Retinal fundus photograph — 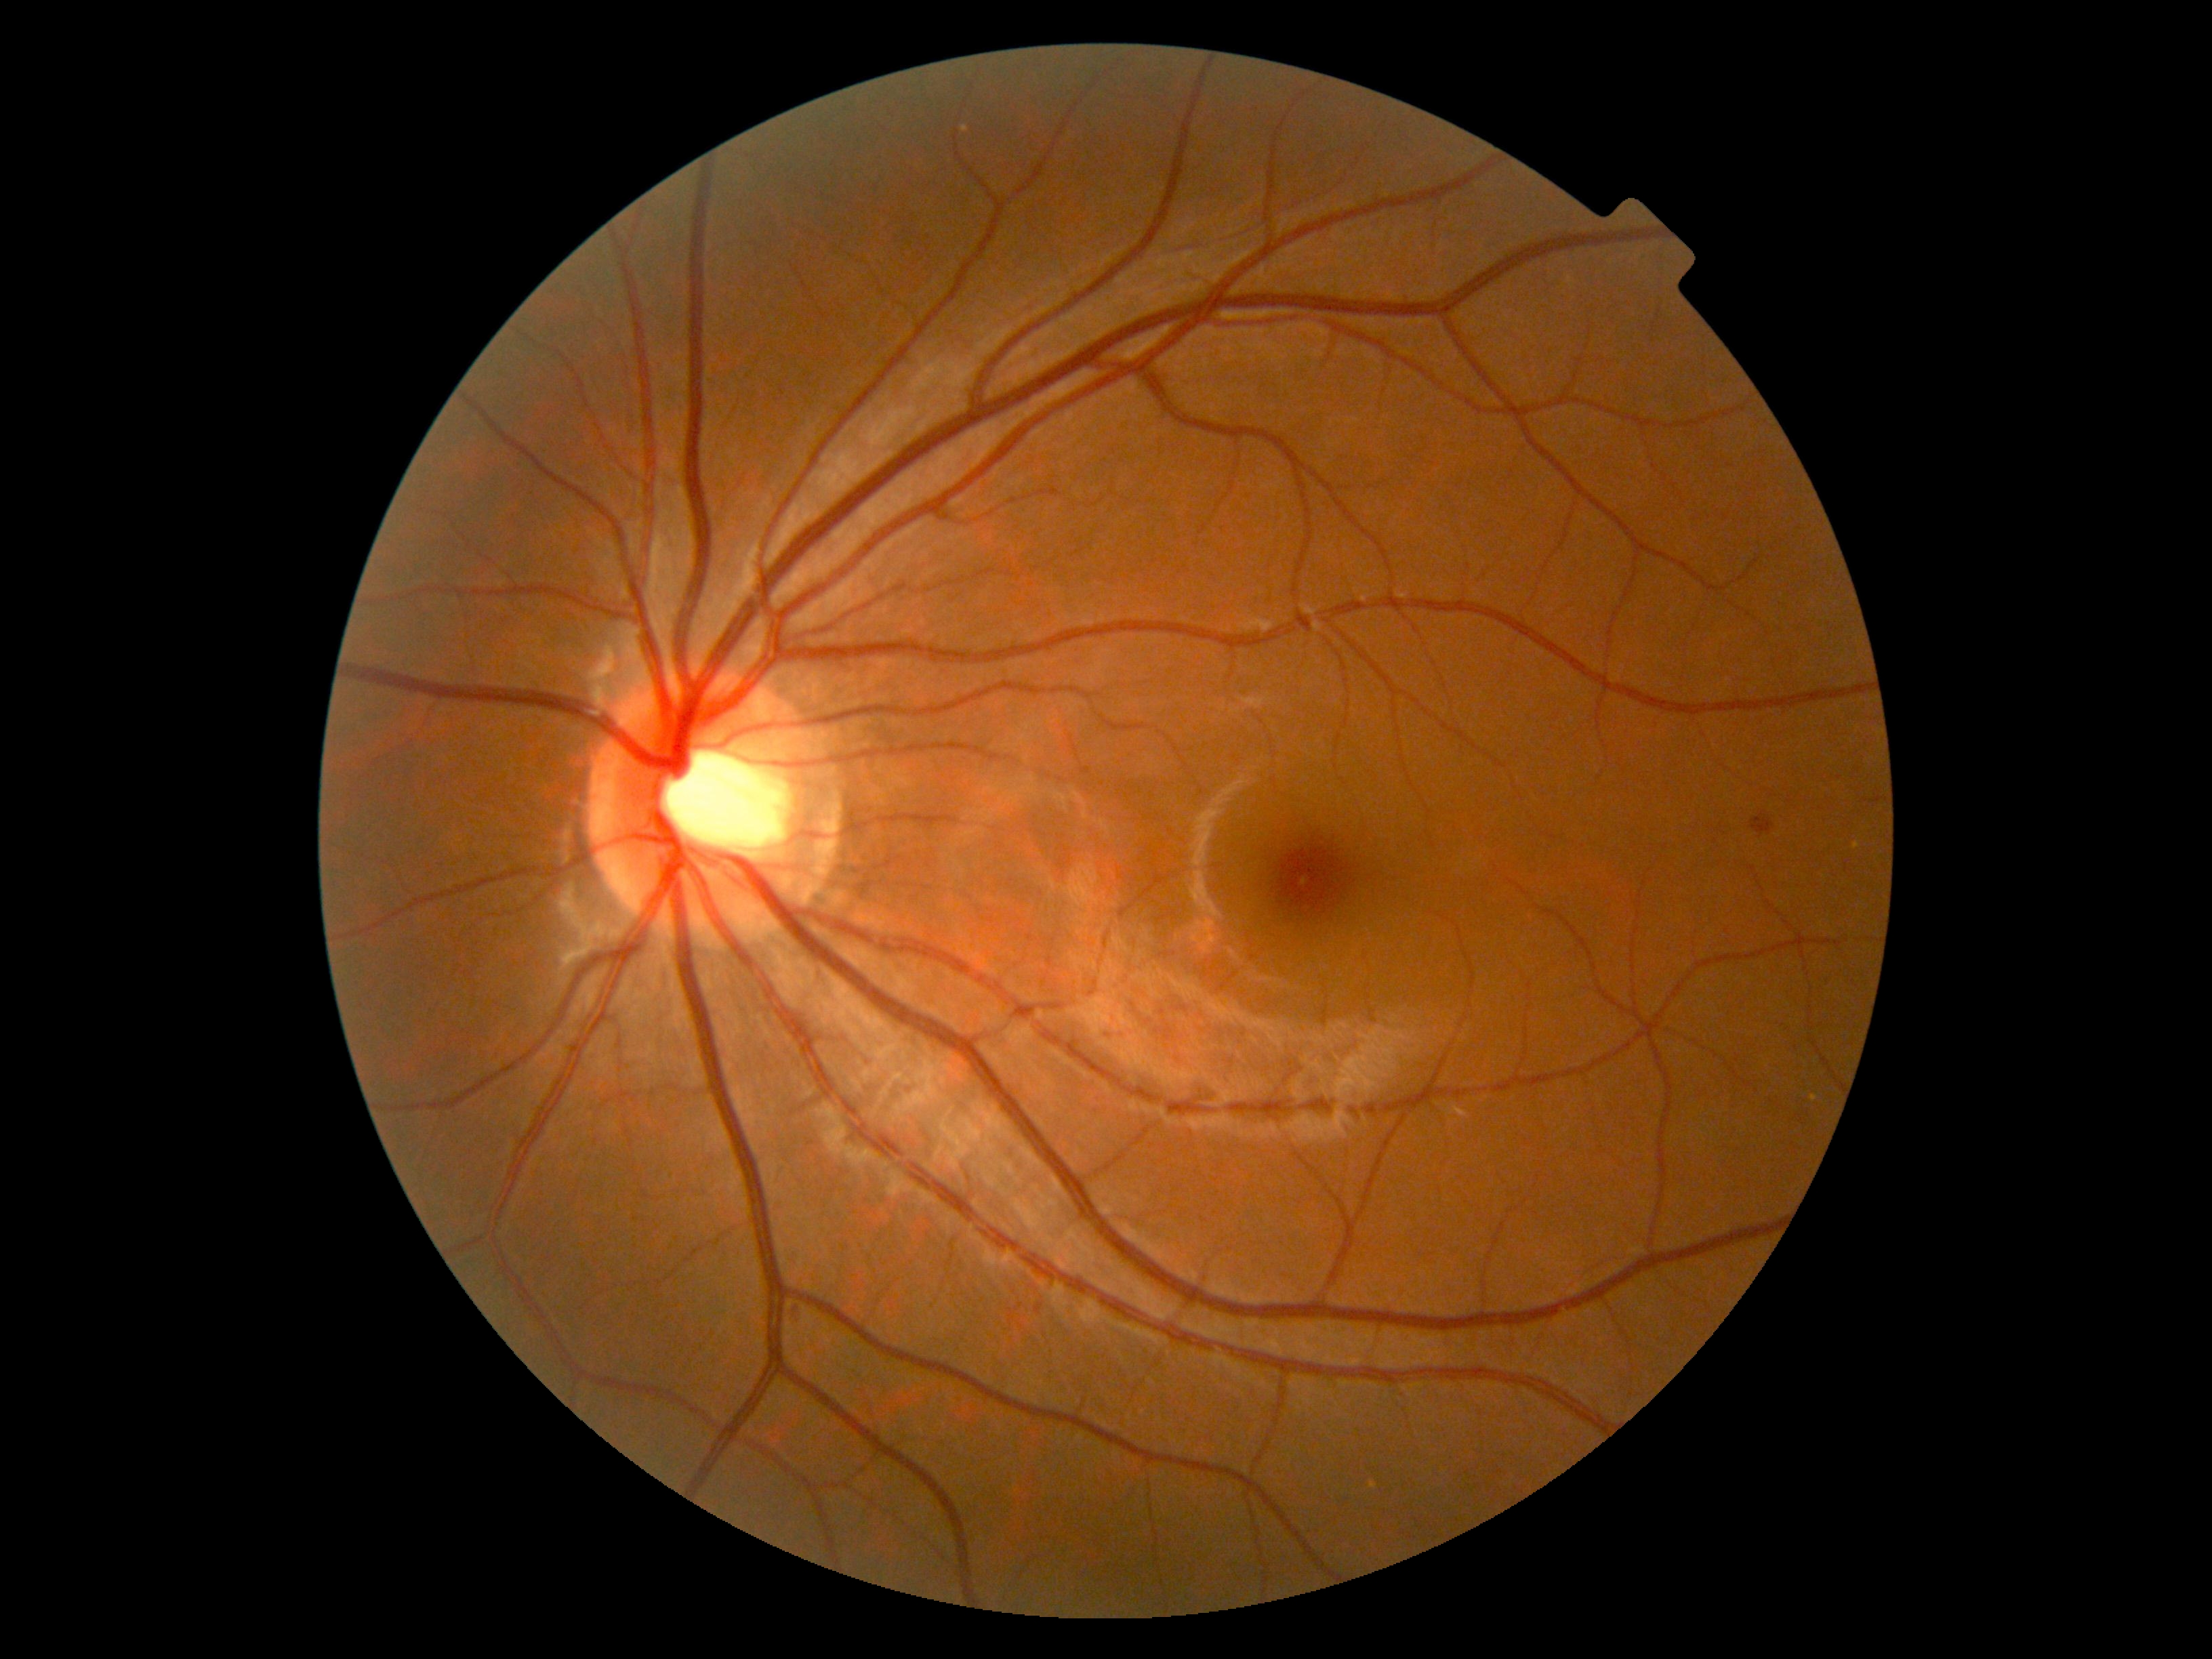 DR: moderate NPDR (grade 2) — more than just microaneurysms but less than severe NPDR.